Wide-field fundus photograph from neonatal ROP screening:
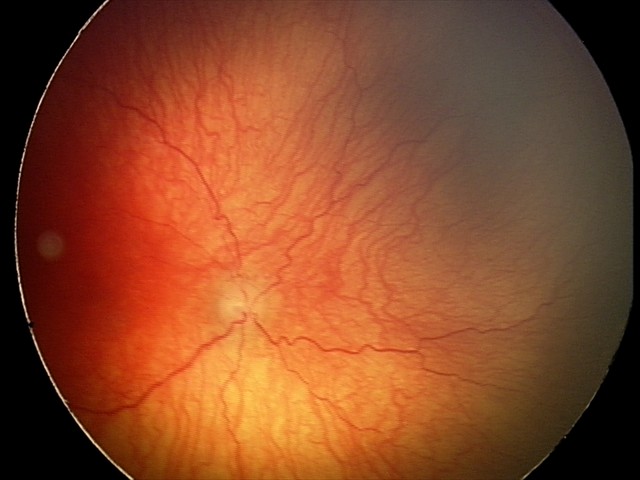 Screening examination consistent with aggressive retinopathy of prematurity (A-ROP).